Retinal fundus photograph, 2352x1568
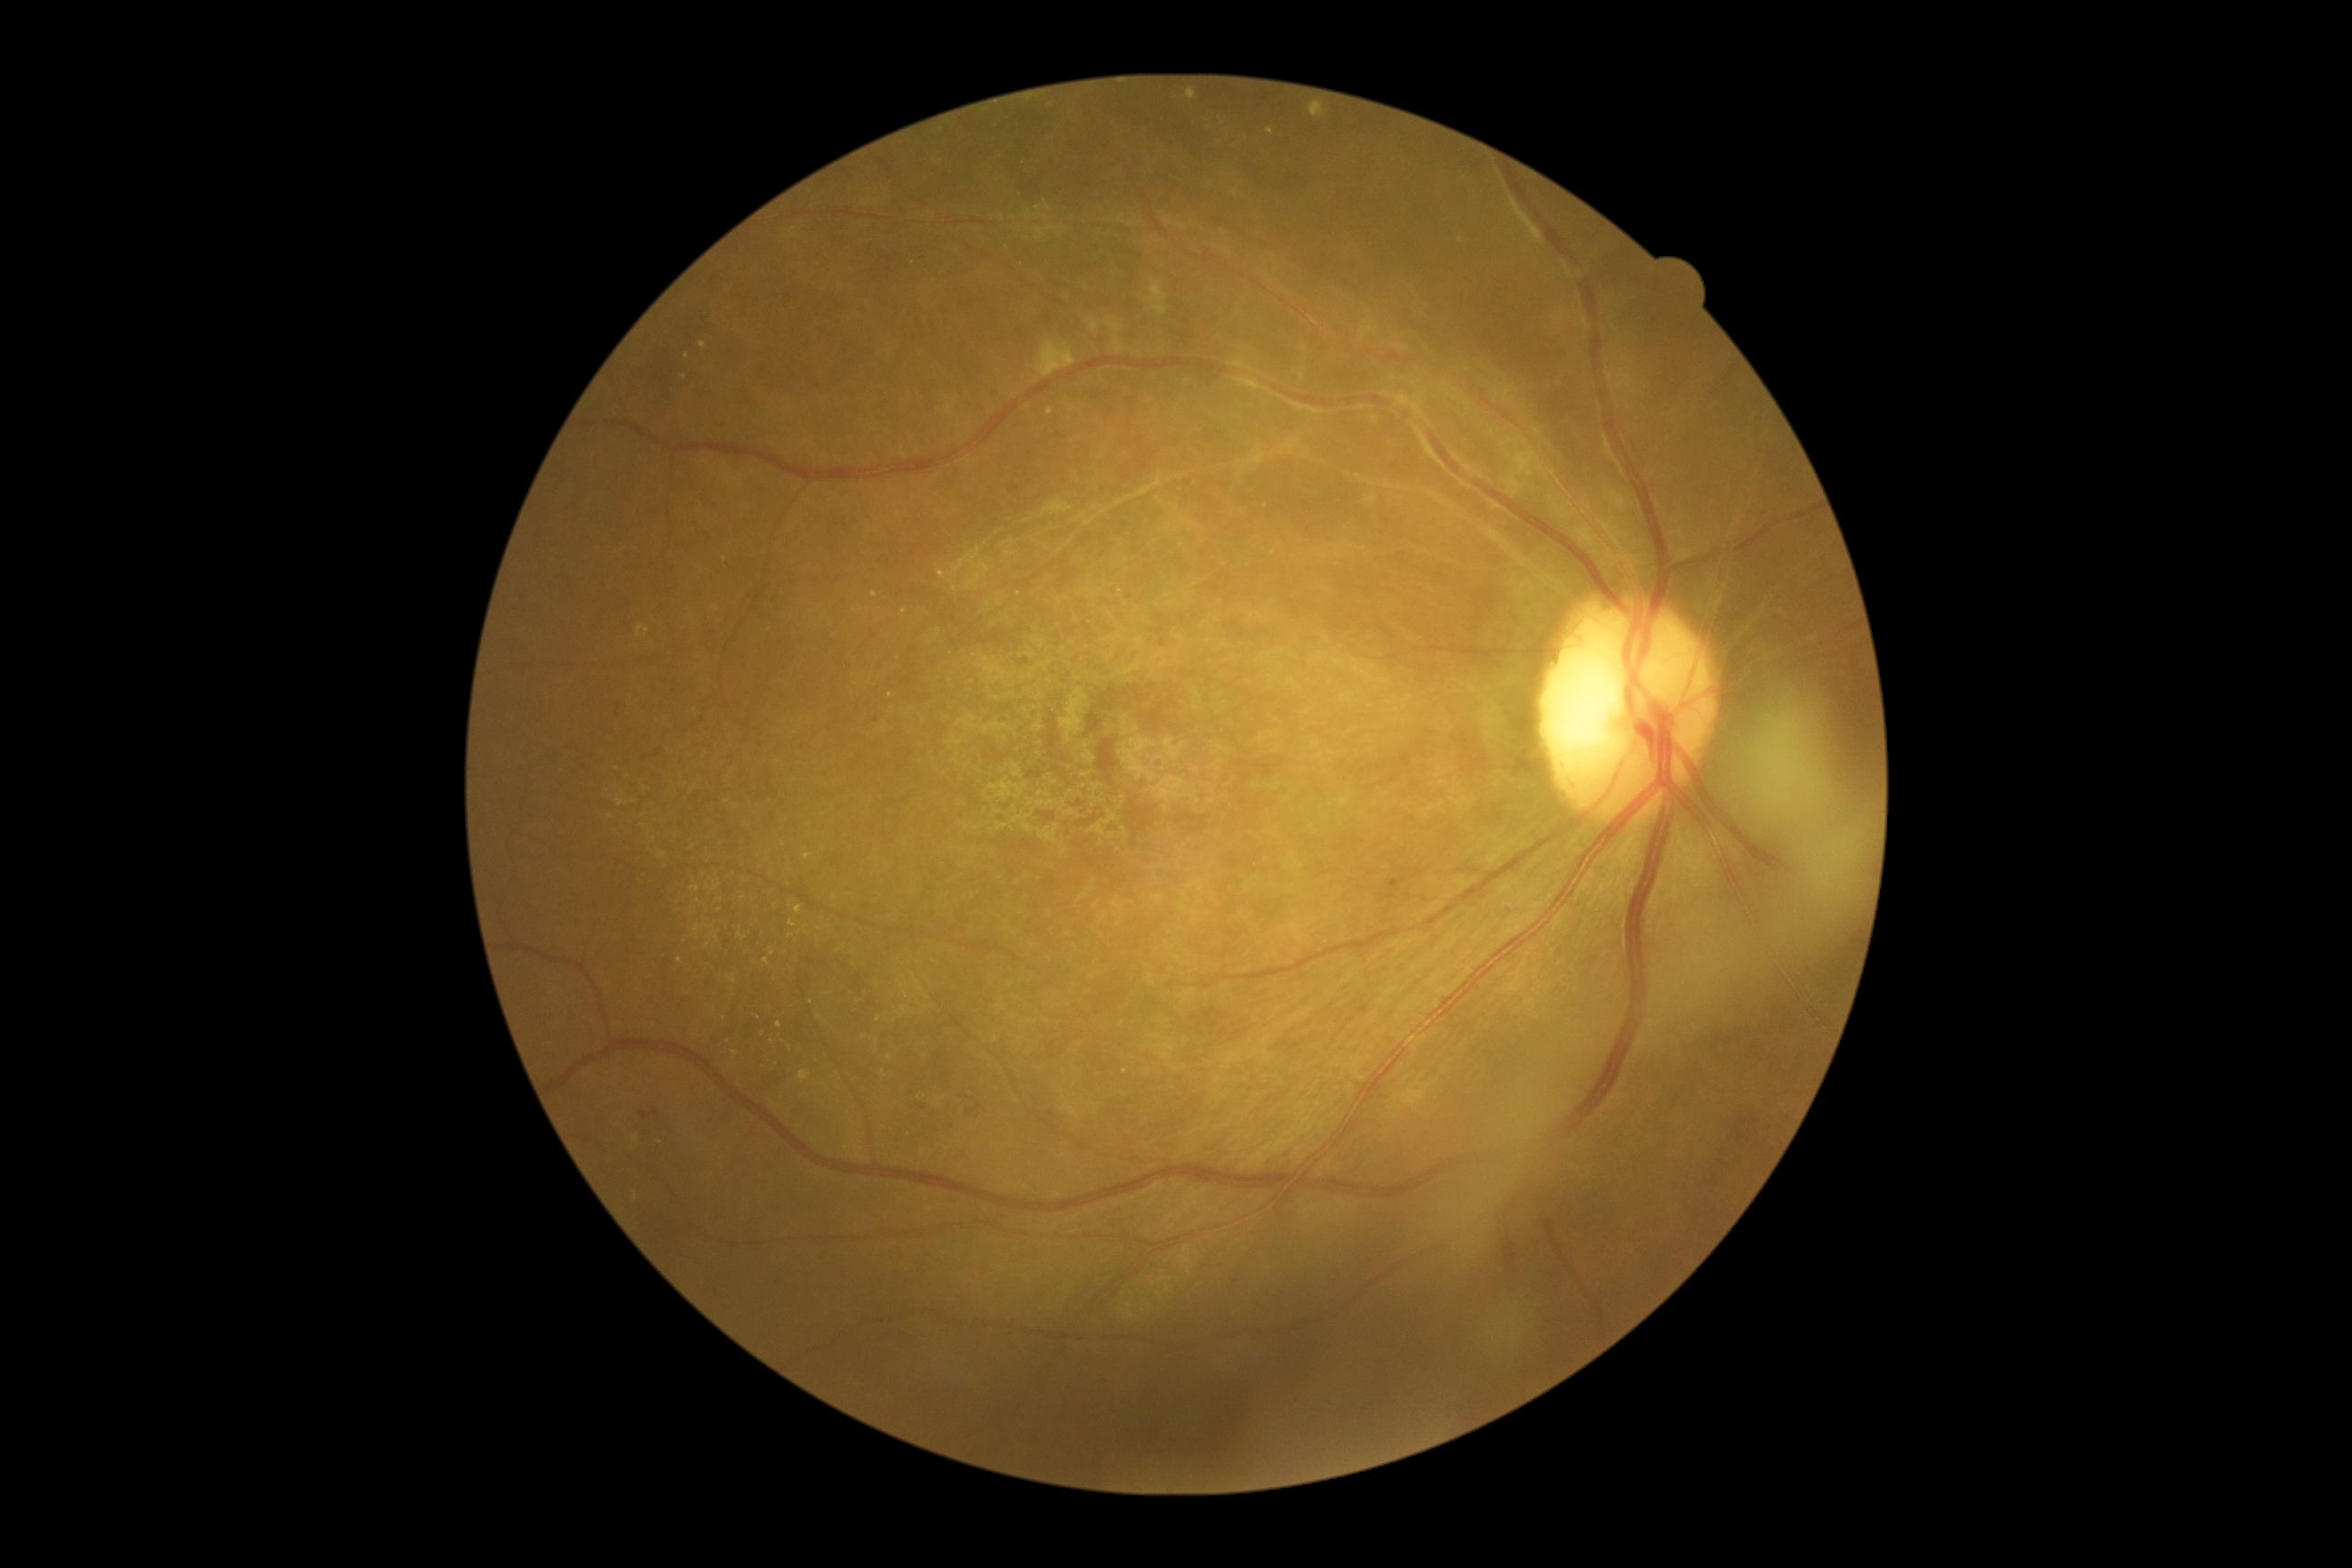
Diabetic retinopathy (DR) is 2/4.
The retinopathy is classified as non-proliferative diabetic retinopathy.